Posterior pole photograph. DR severity per modified Davis staging. Acquired with a NIDEK AFC-230. 848 x 848 pixels:
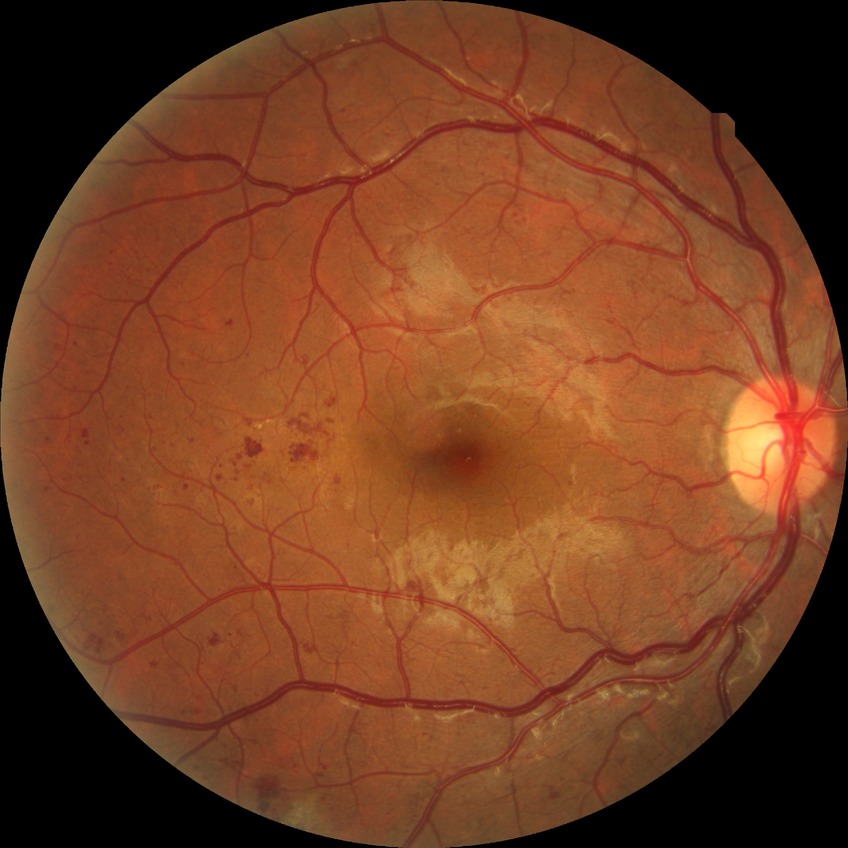
Diabetic retinopathy (DR): proliferative diabetic retinopathy (PDR).